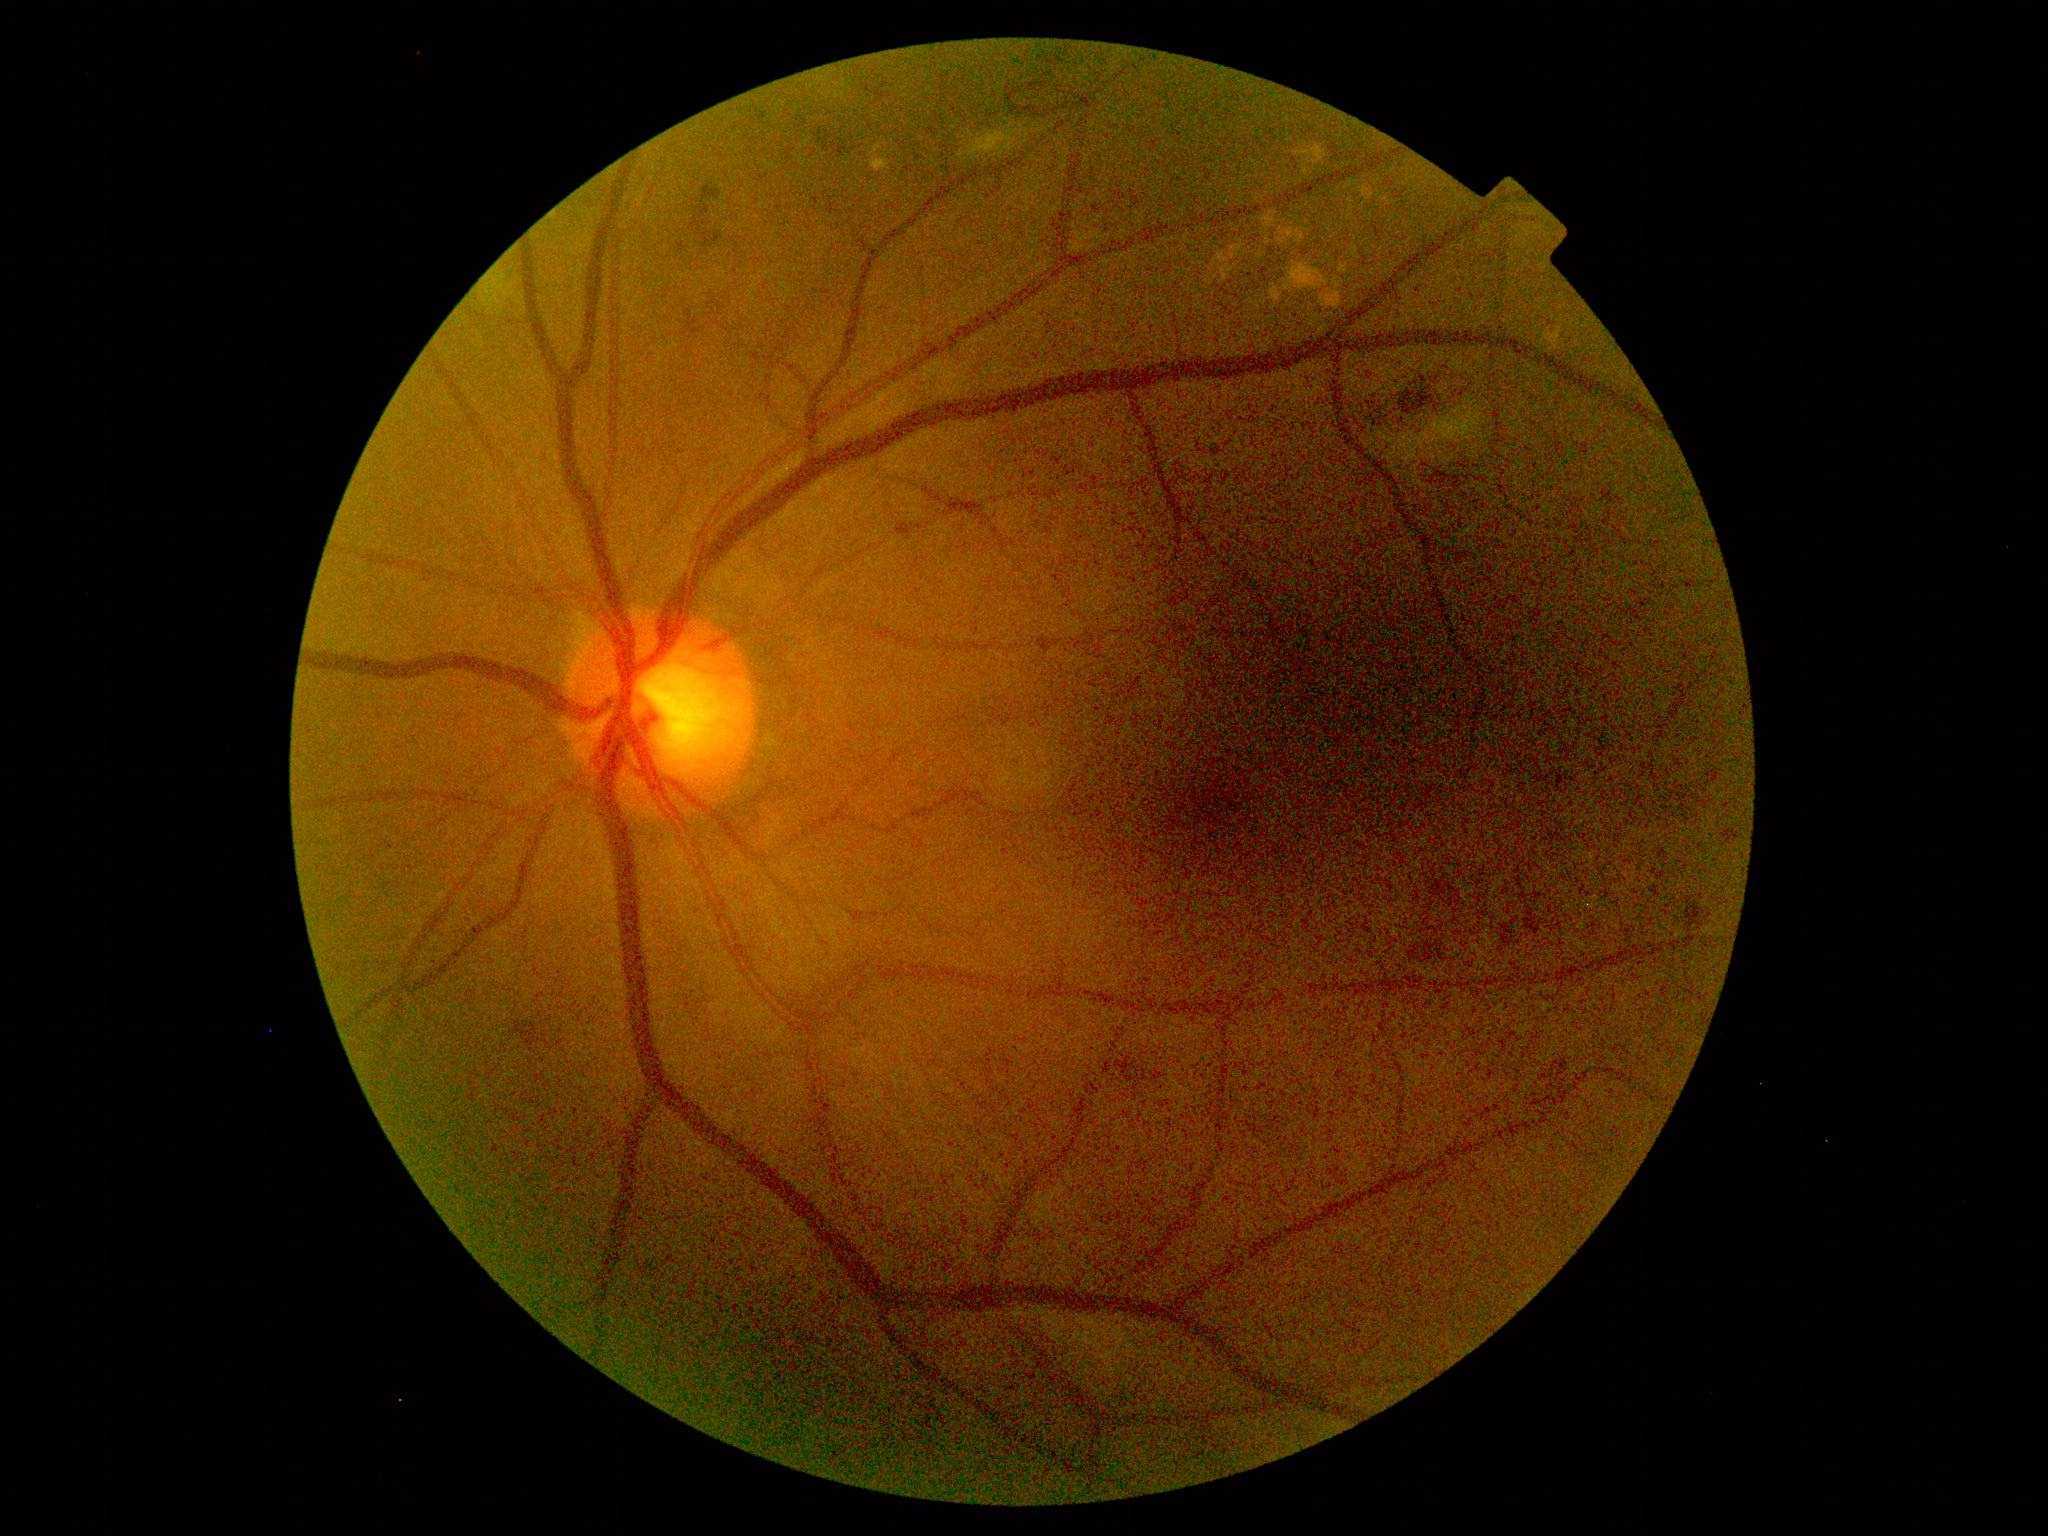
Retinopathy grade: 2.